848x848, Davis DR grading, color fundus photograph:
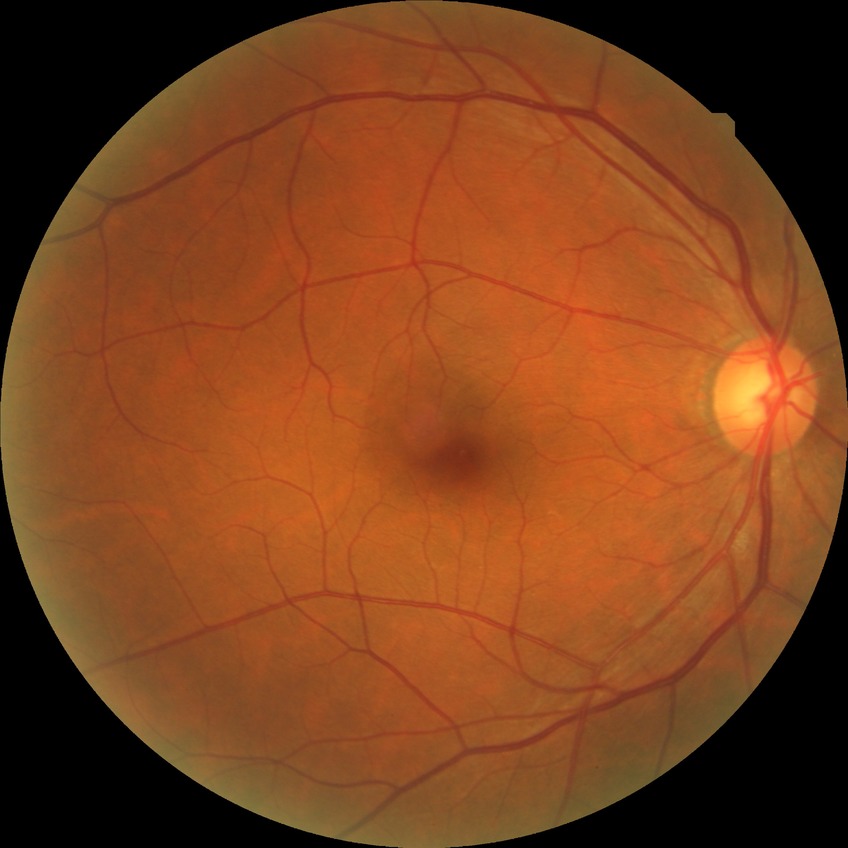
Assessment:
• diabetic retinopathy (DR) — no diabetic retinopathy (NDR)